Nonmydriatic fundus photograph.
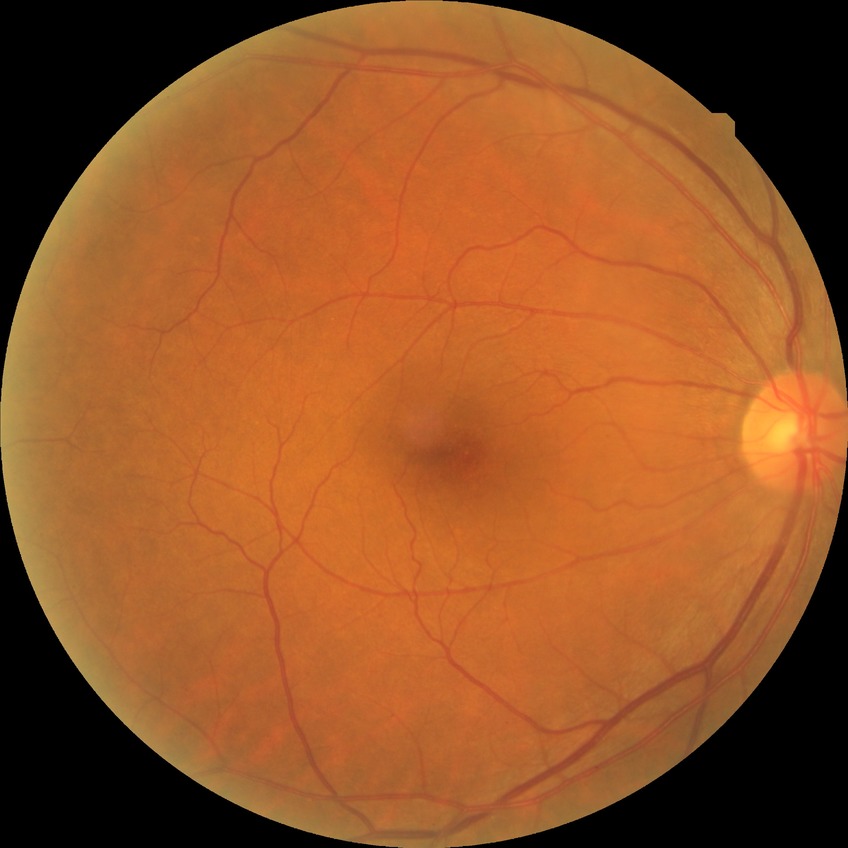
Assessment:
- diabetic retinopathy (DR) — no diabetic retinopathy (NDR)